45° FOV · 2368x1568px: 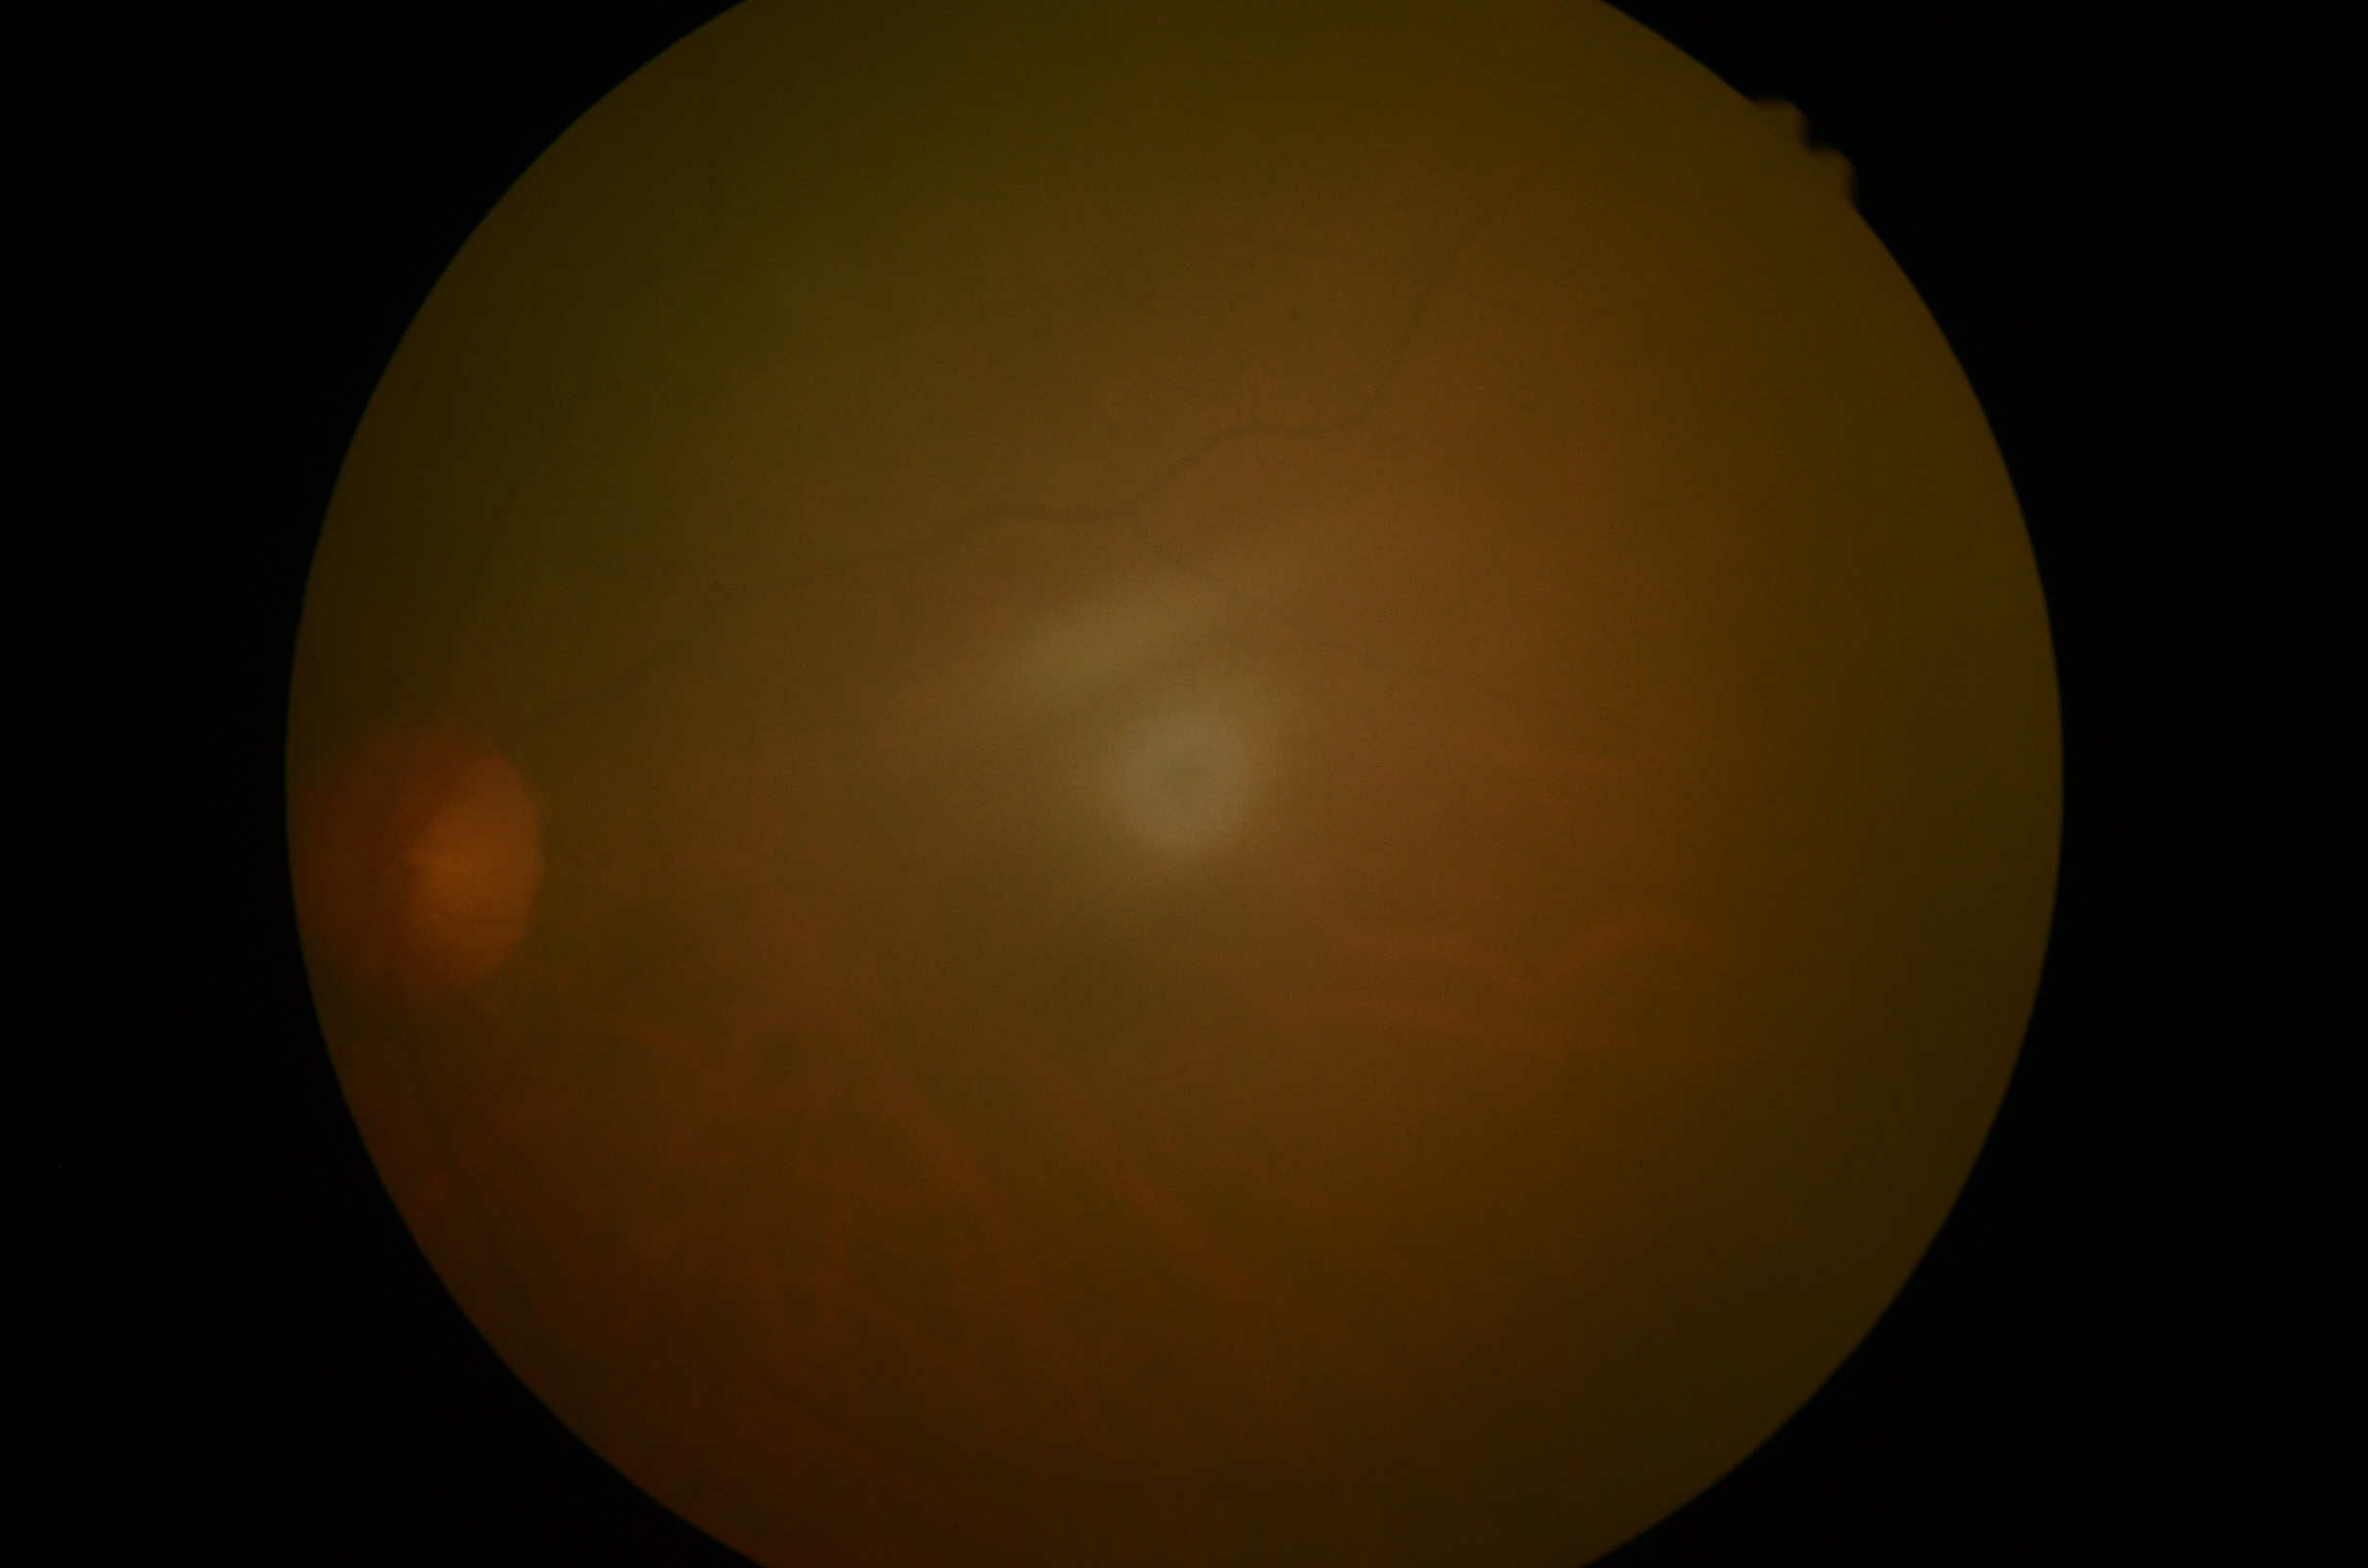
Annotations:
- image quality: insufficient for DR assessment
- DR stage: ungradable due to poor image quality